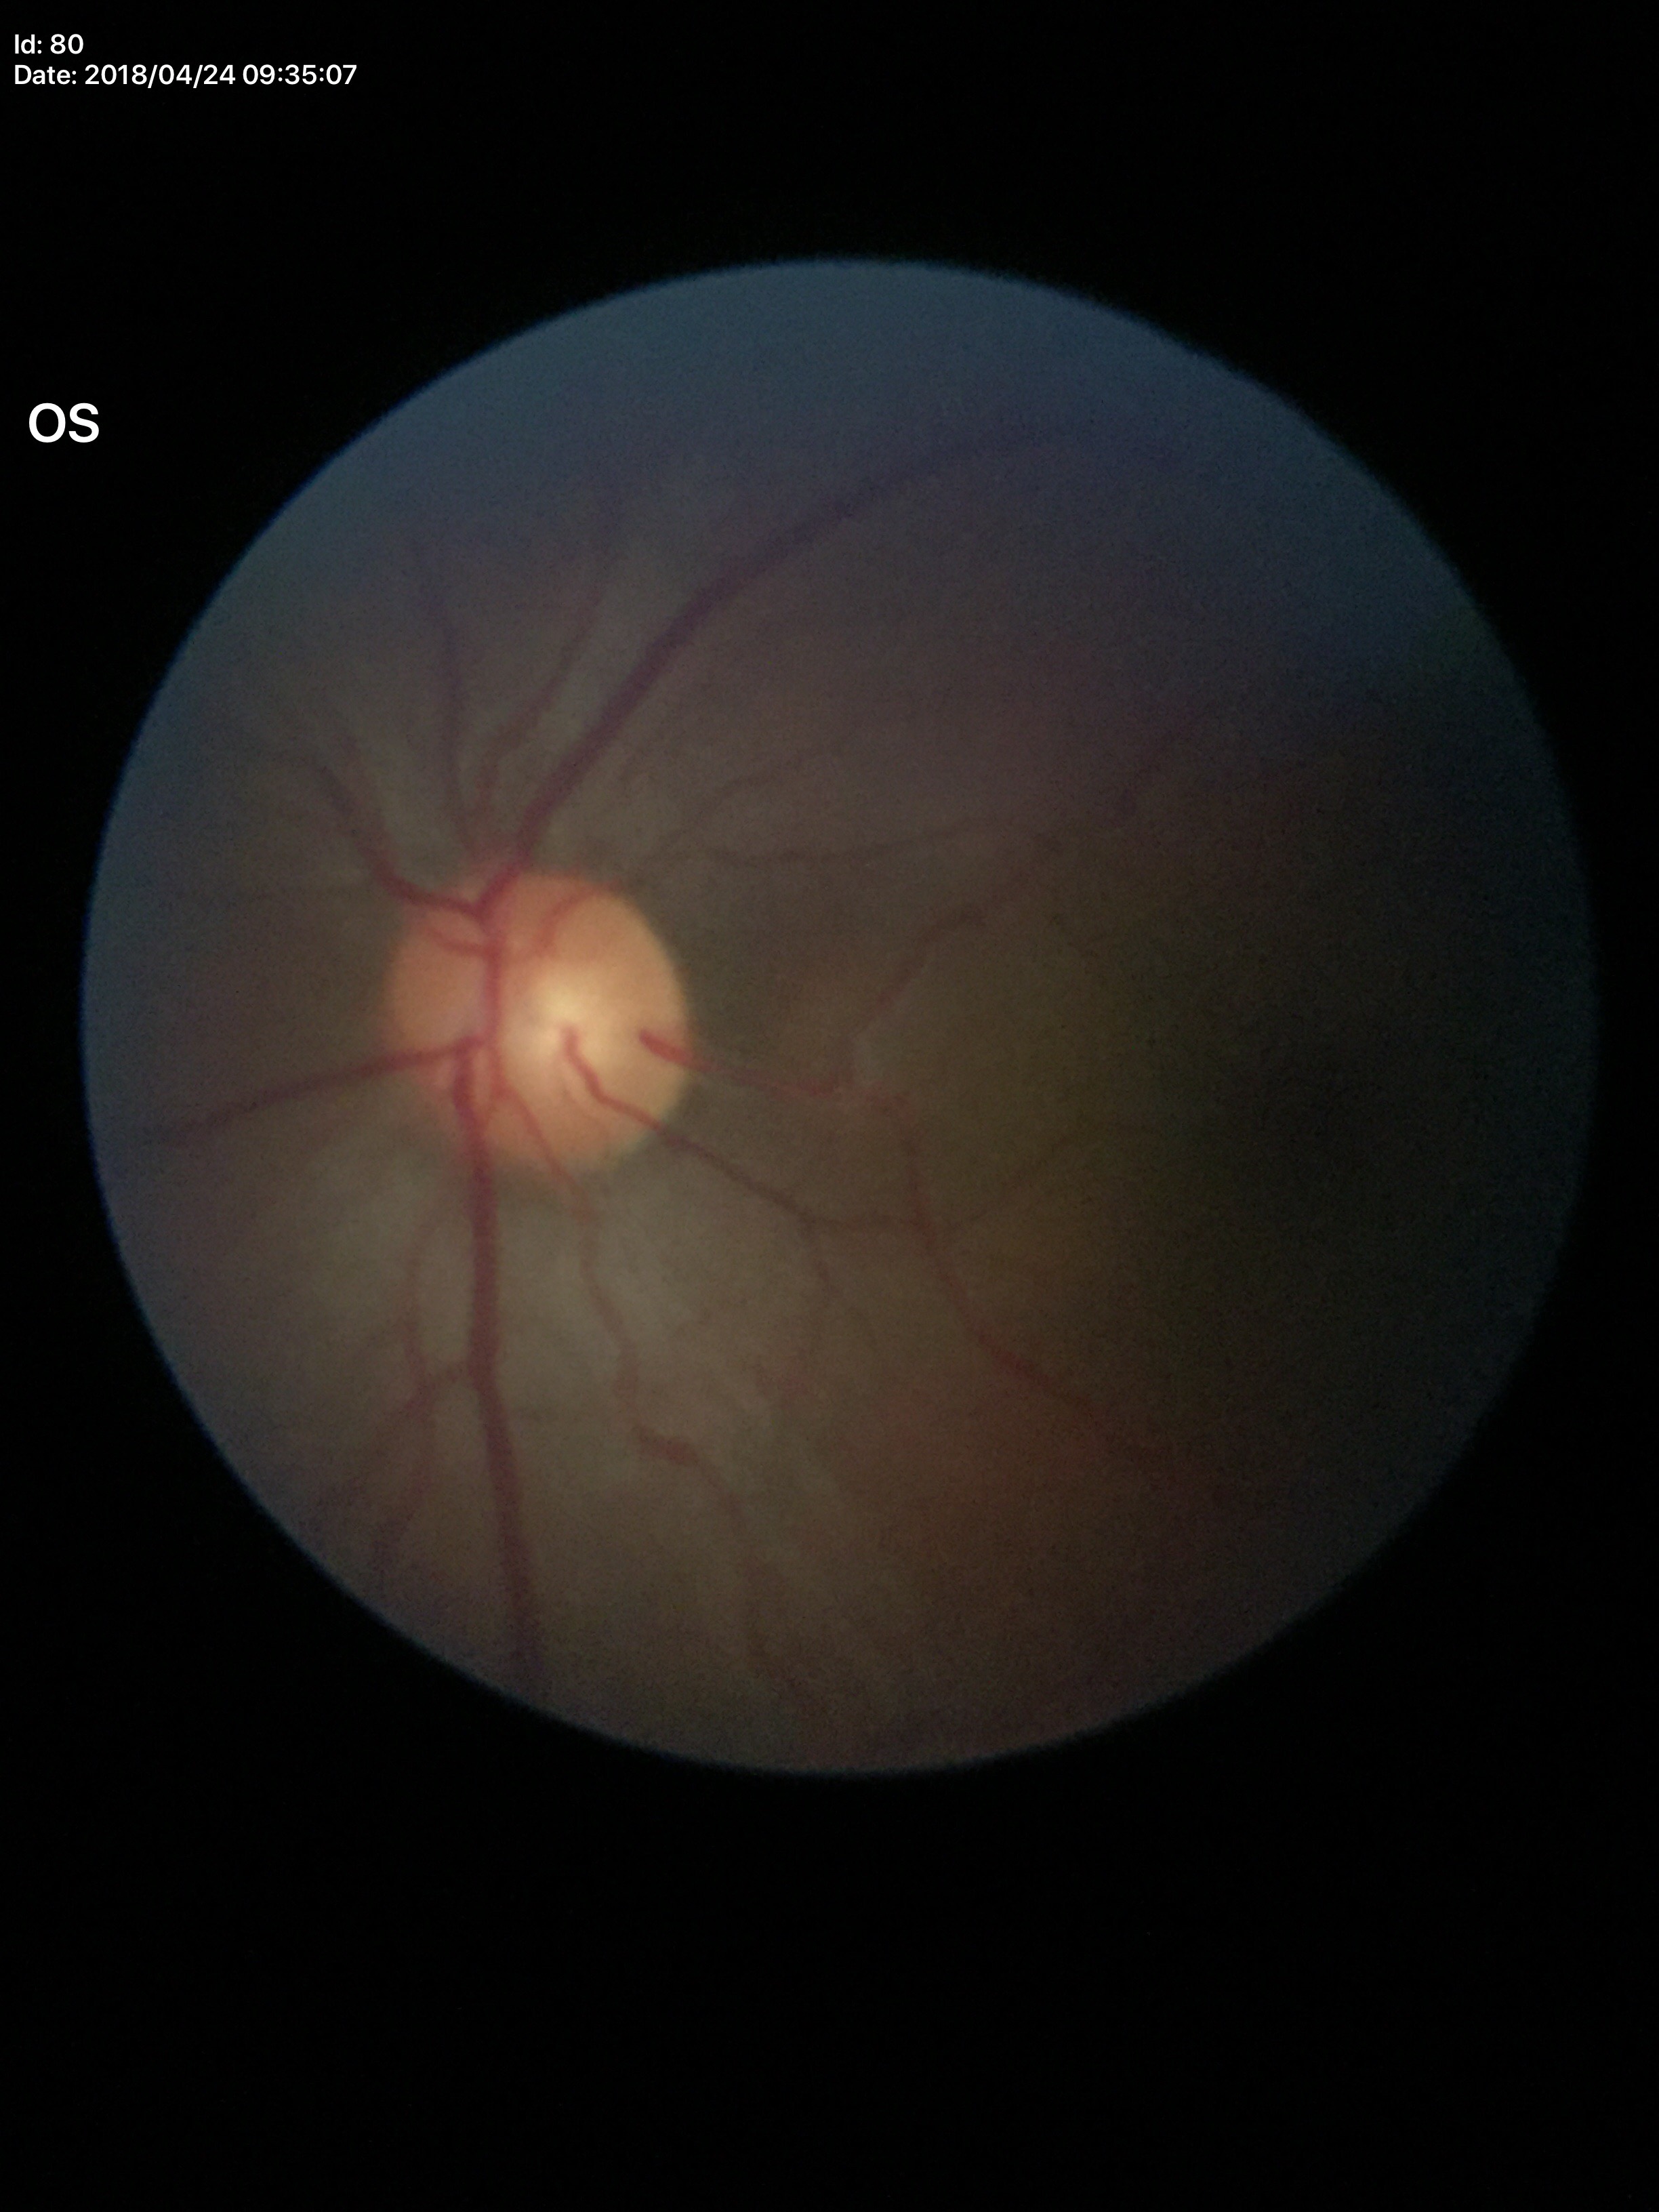
Glaucoma impression: no suspicious findings | vertical C/D ratio (VCDR): 0.49 | horizontal CDR (HCDR): 0.51.